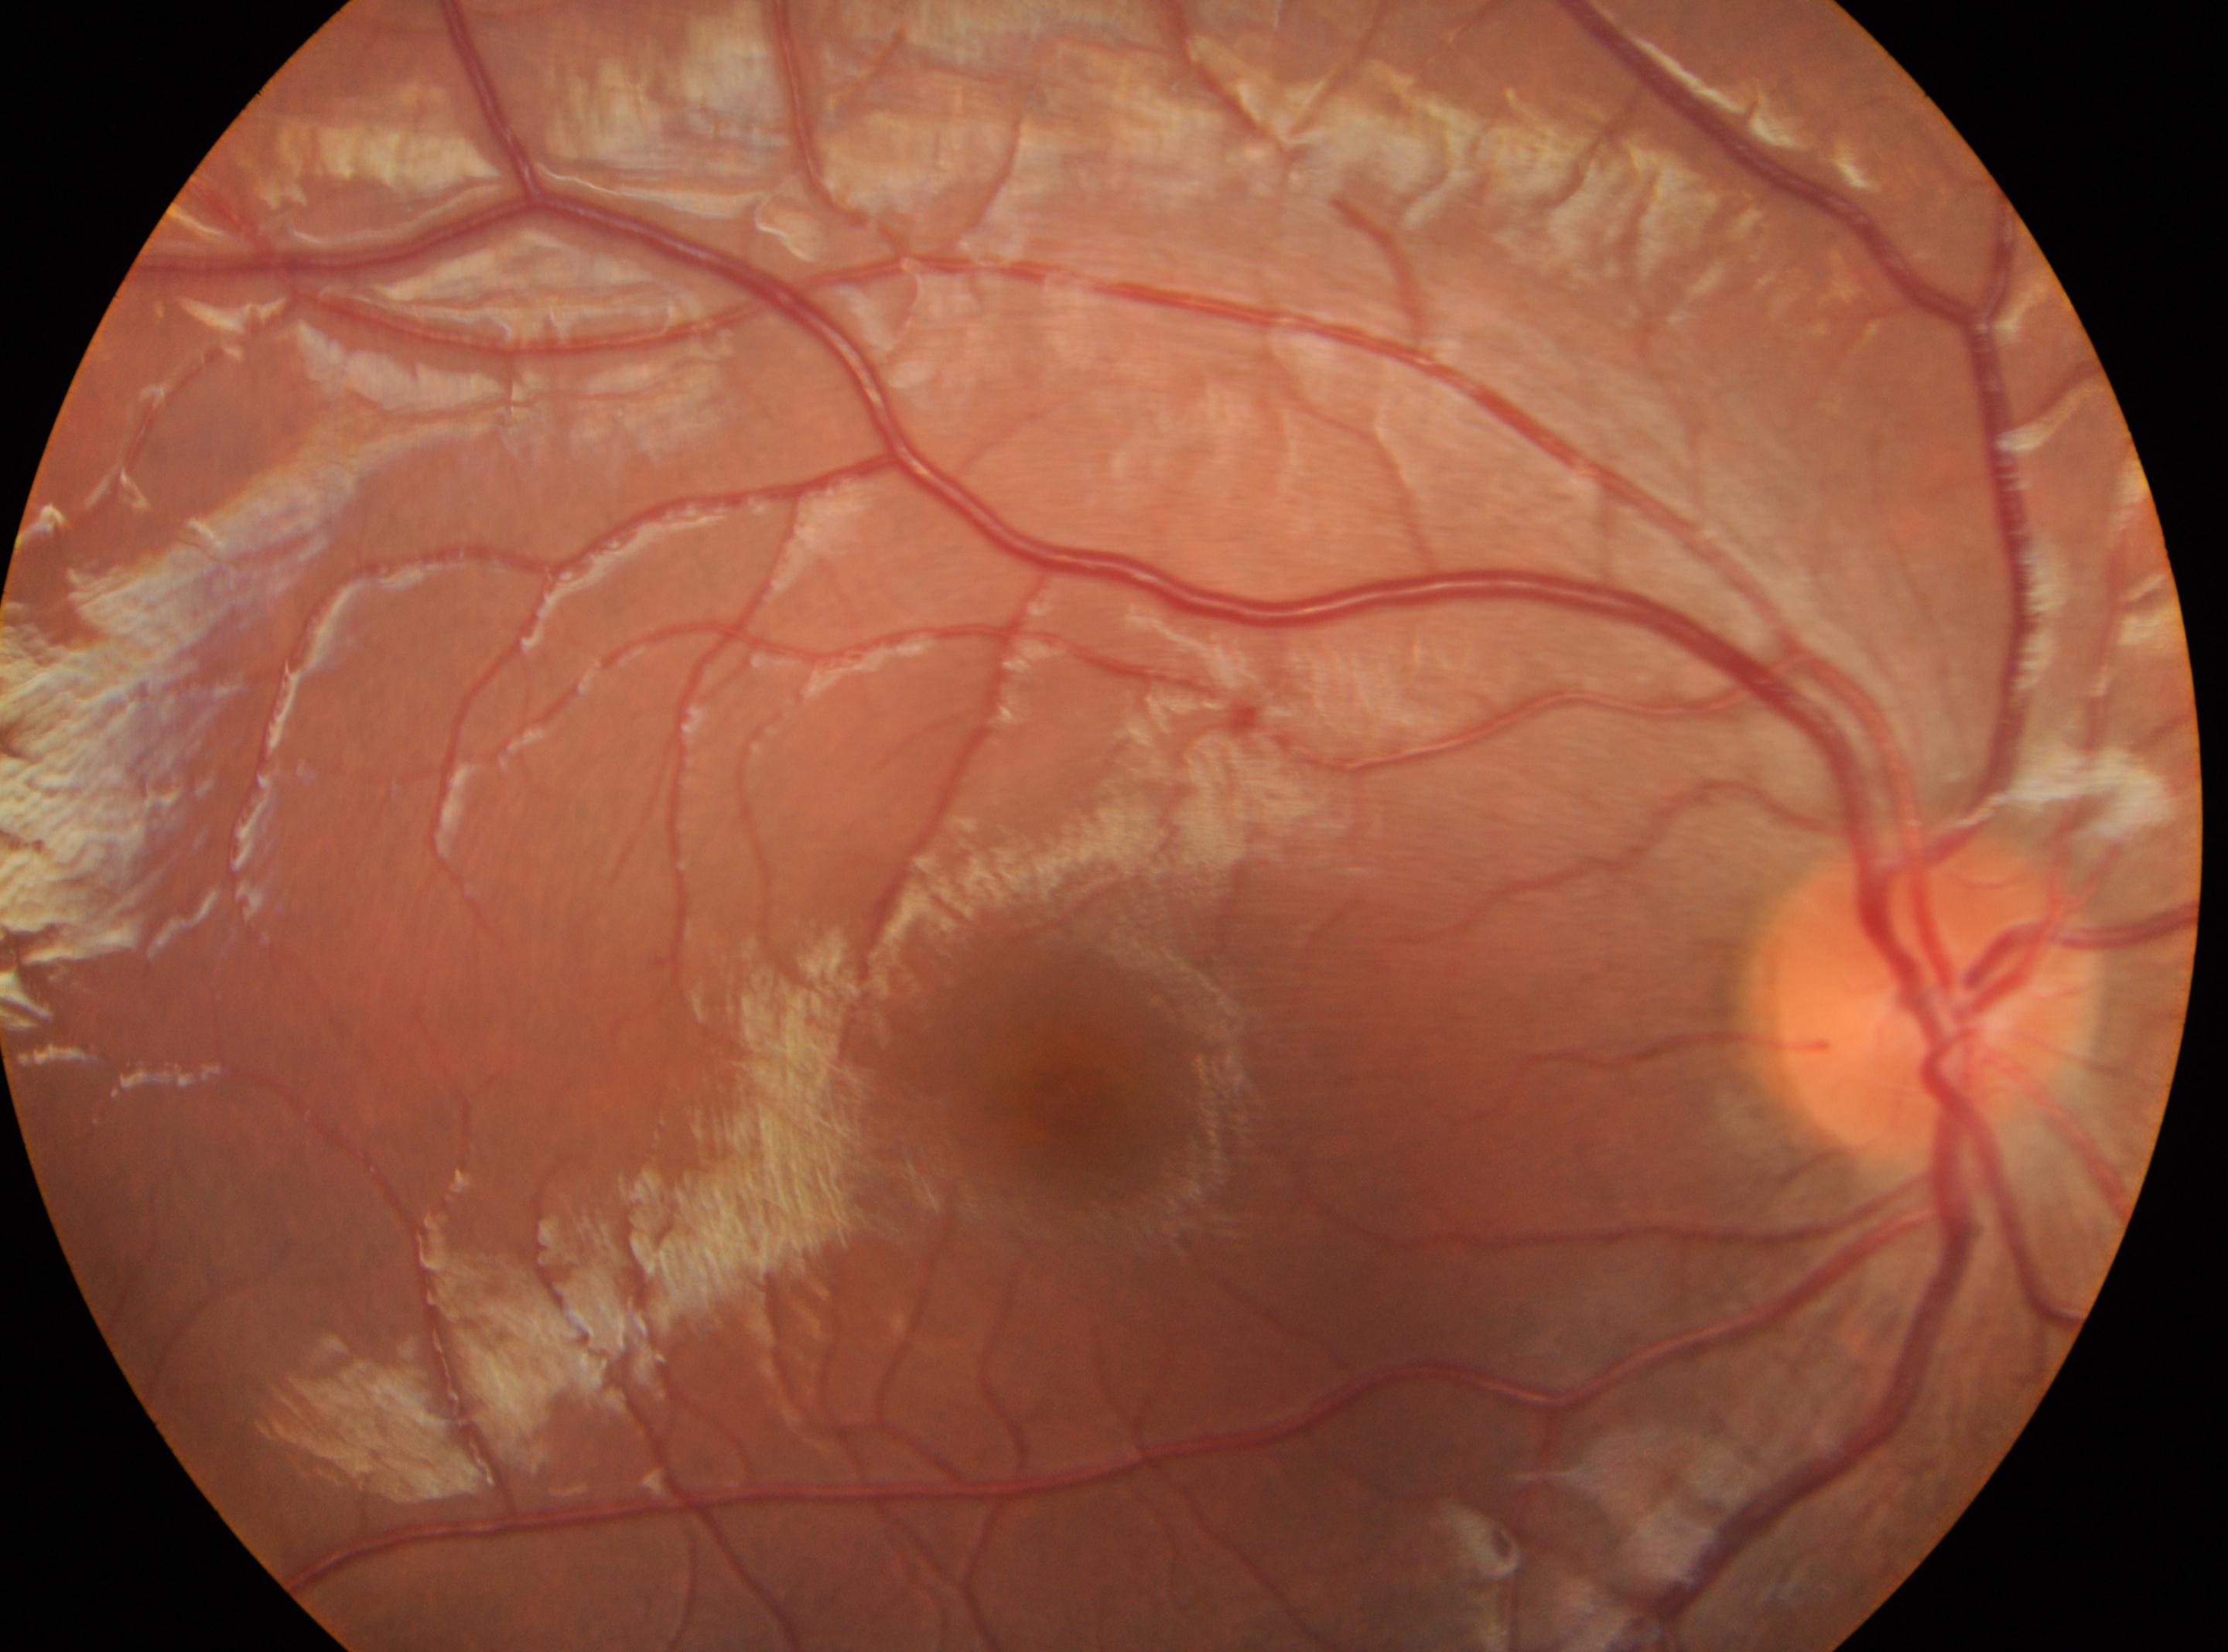
OD; DR grade: 0 (no apparent retinopathy); foveal center: 1069, 1097; optic nerve head: 1937, 993; No signs of diabetic retinopathy.